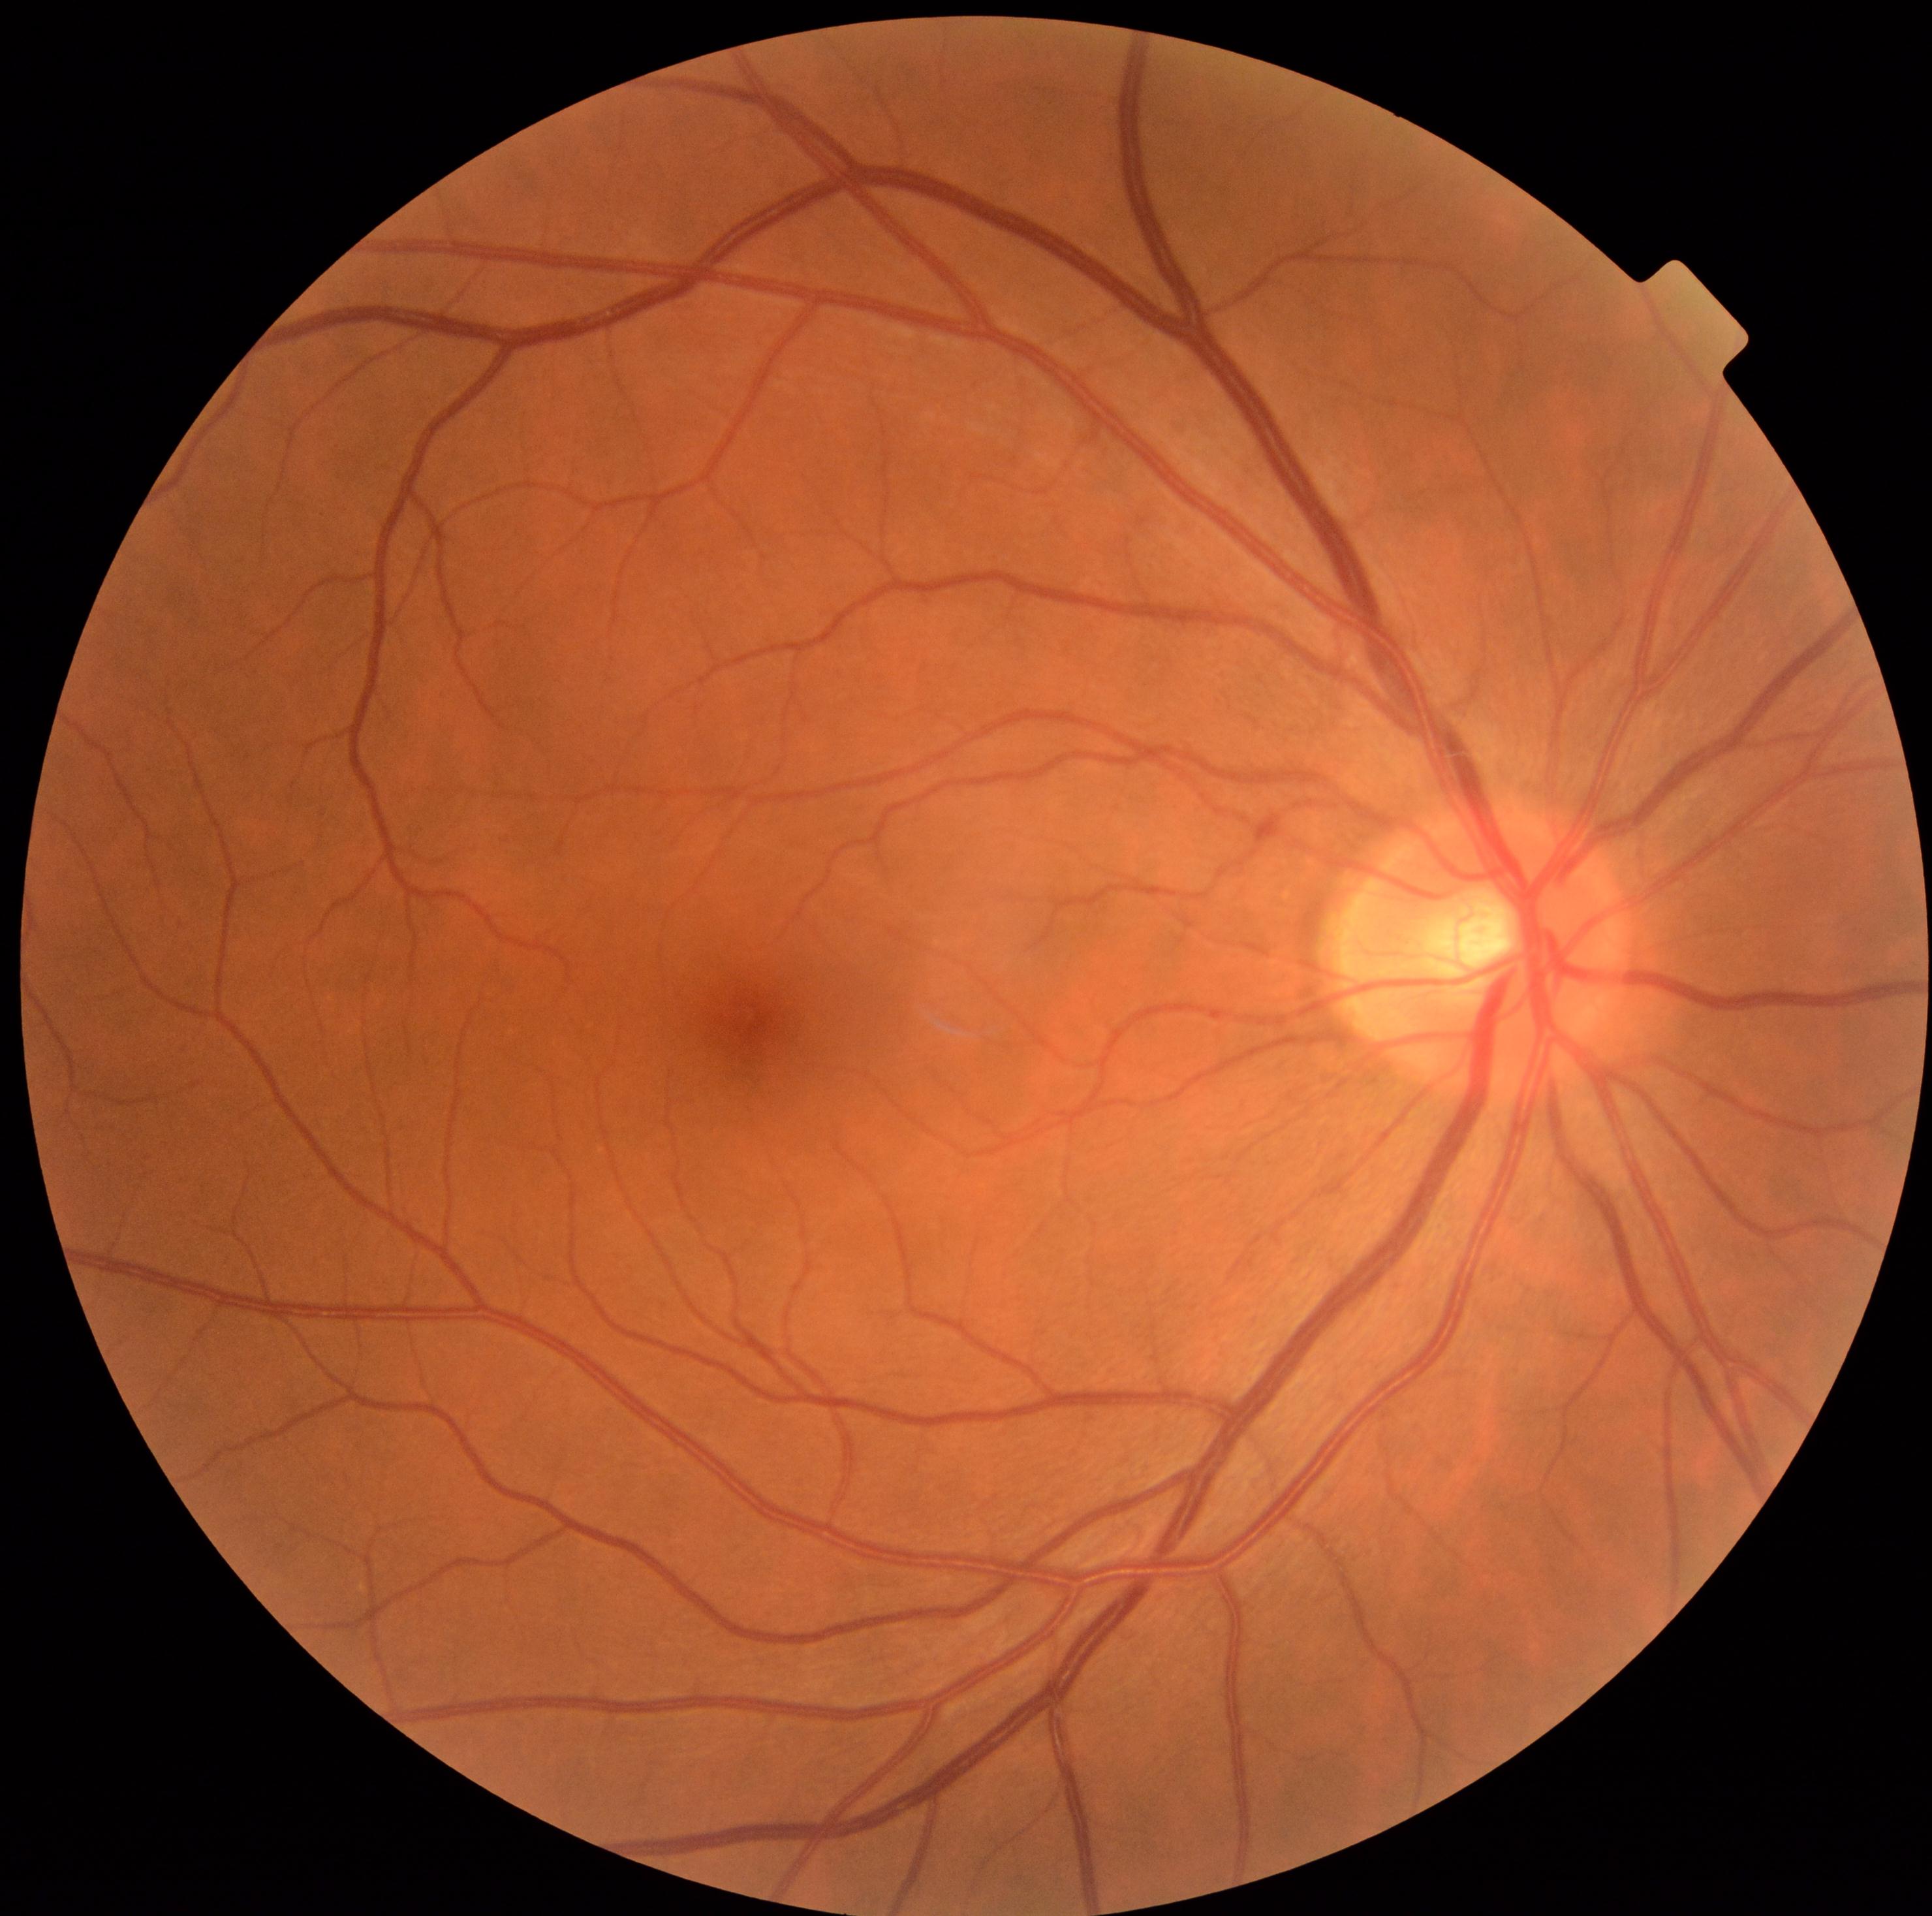
Diabetic retinopathy grade is 0 (no apparent retinopathy).